640 x 480 pixels. RetCam wide-field infant fundus image: 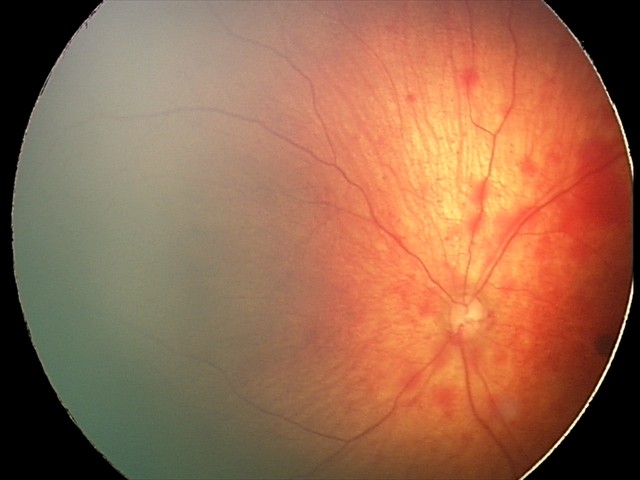
Screening series with retinal hemorrhages.